1380x1382px. 45° field of view.
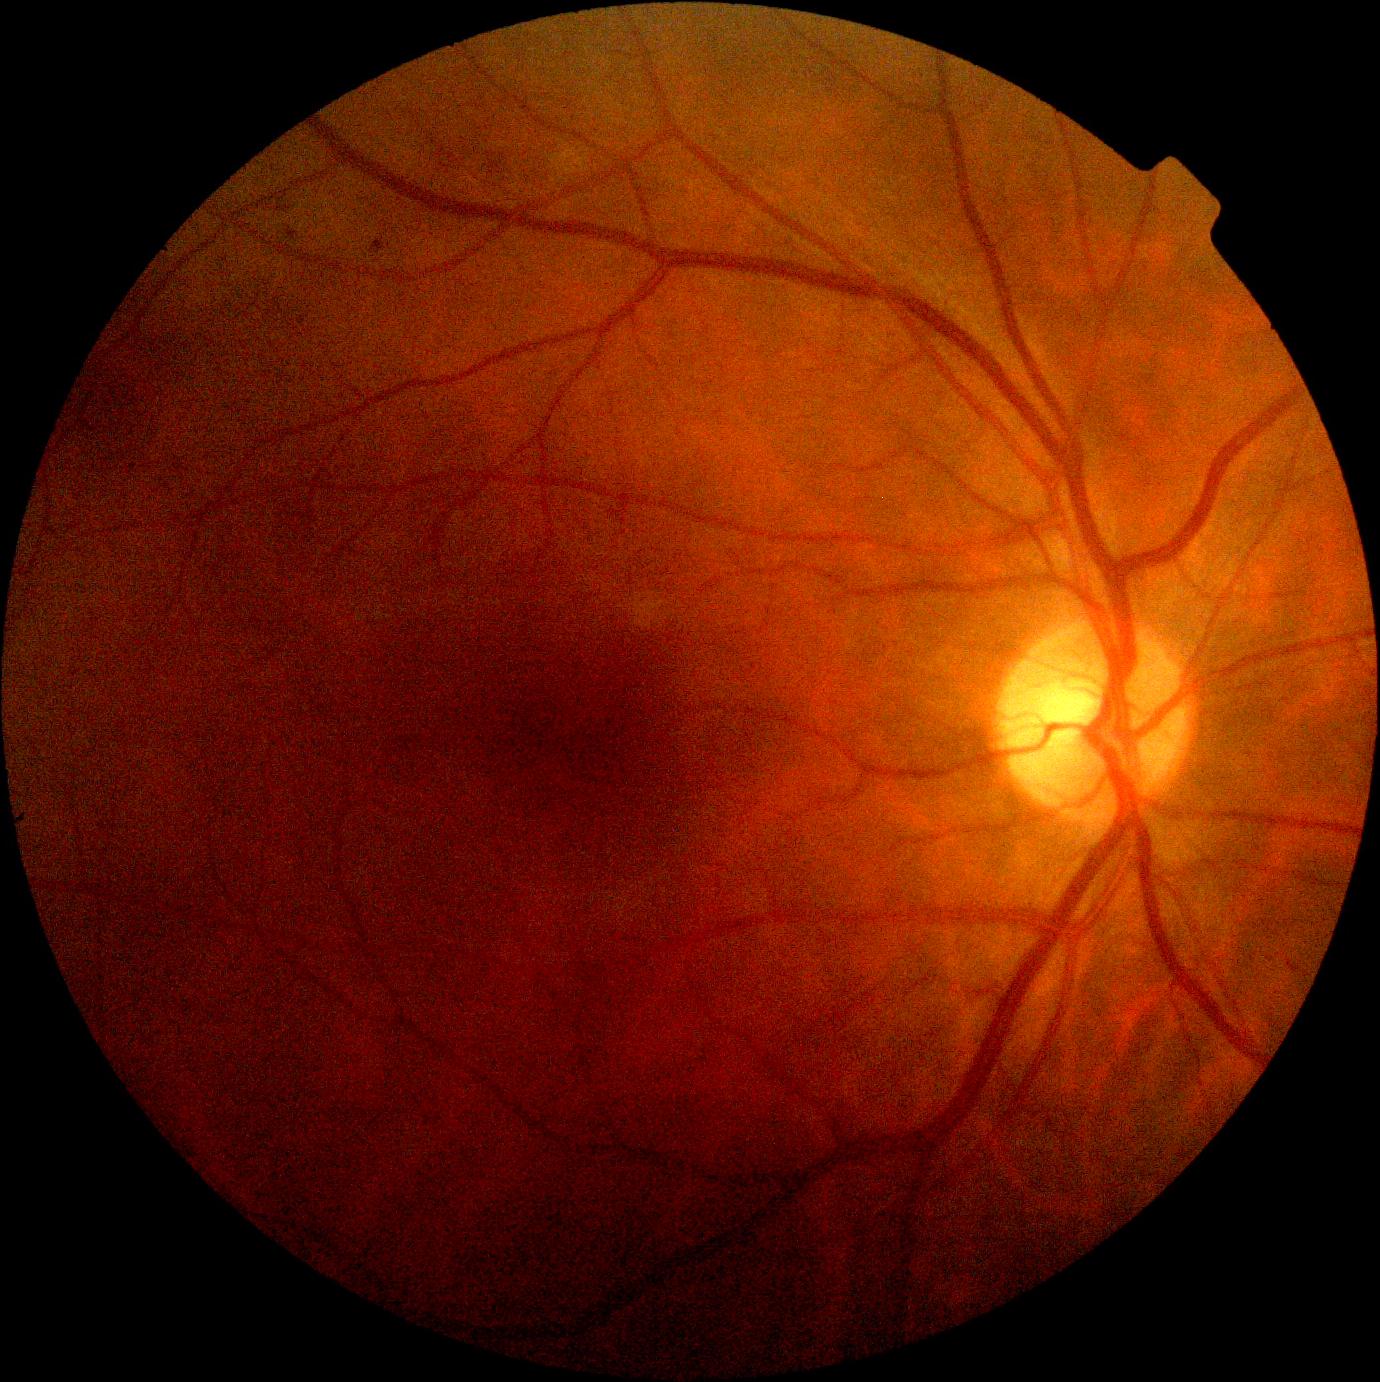
Diabetic retinopathy severity is moderate non-proliferative diabetic retinopathy (grade 2). Disease class: non-proliferative diabetic retinopathy.